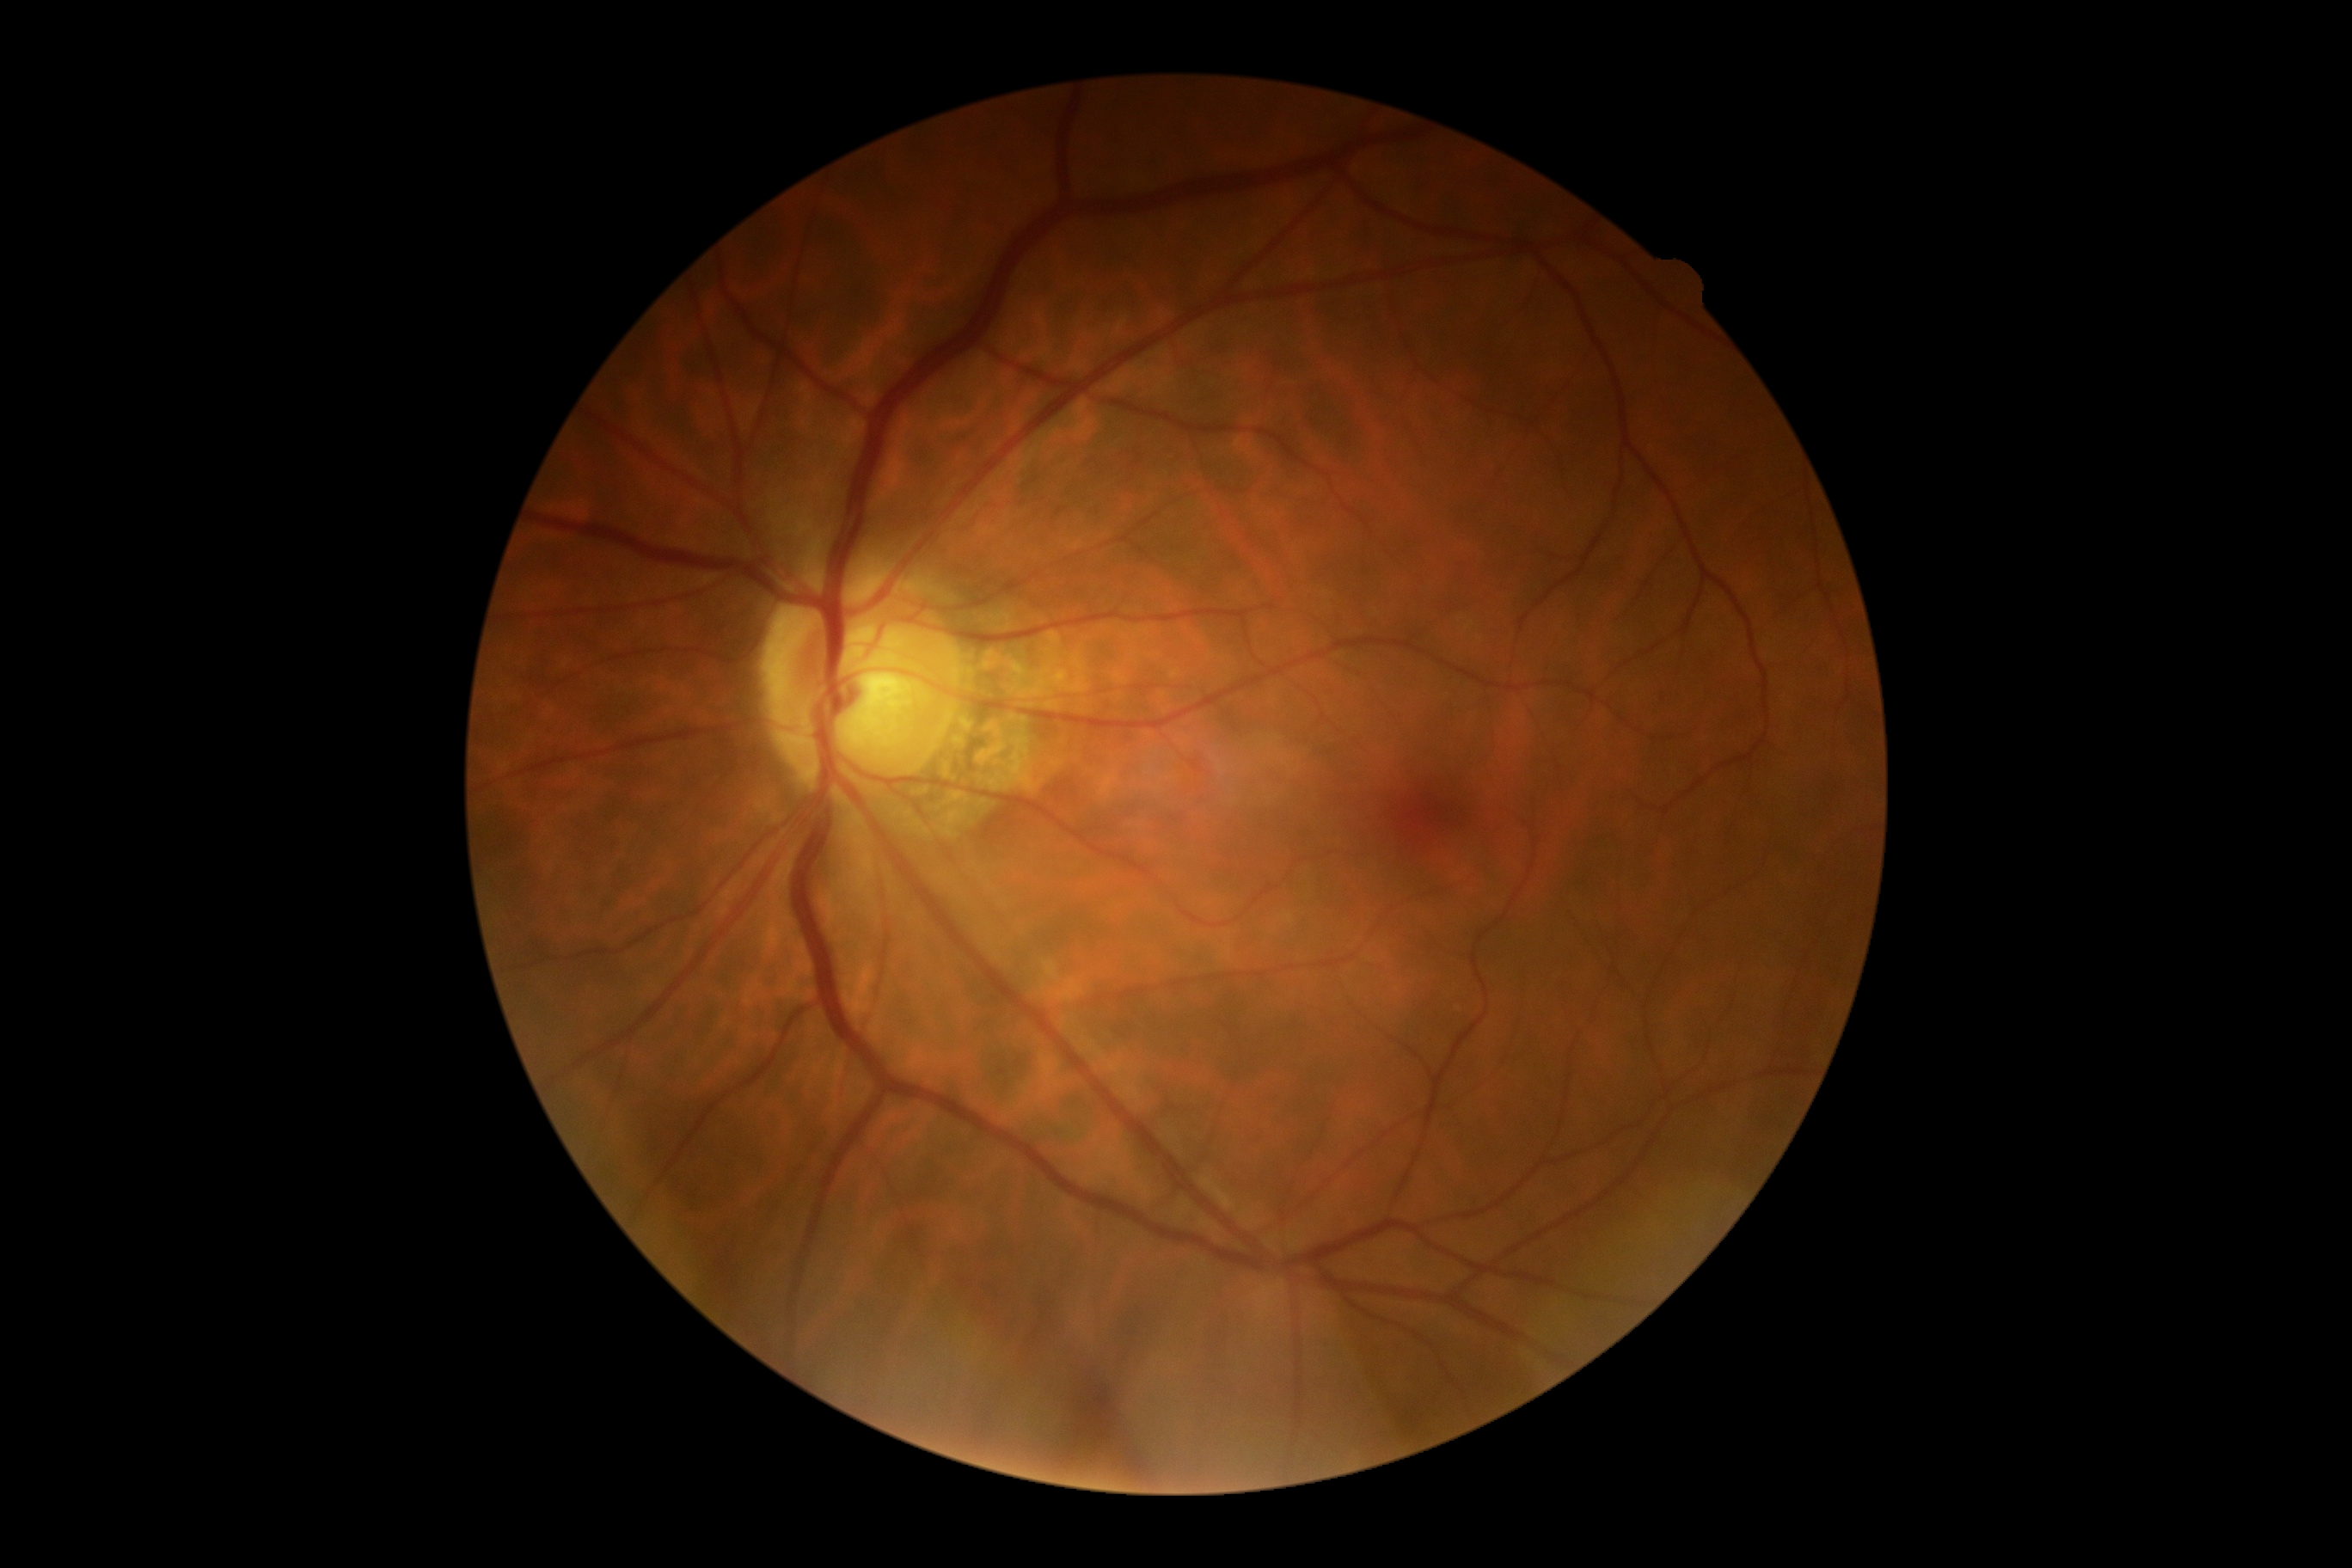

Annotations:
• DR impression: no DR findings
• DR grade: 0/4